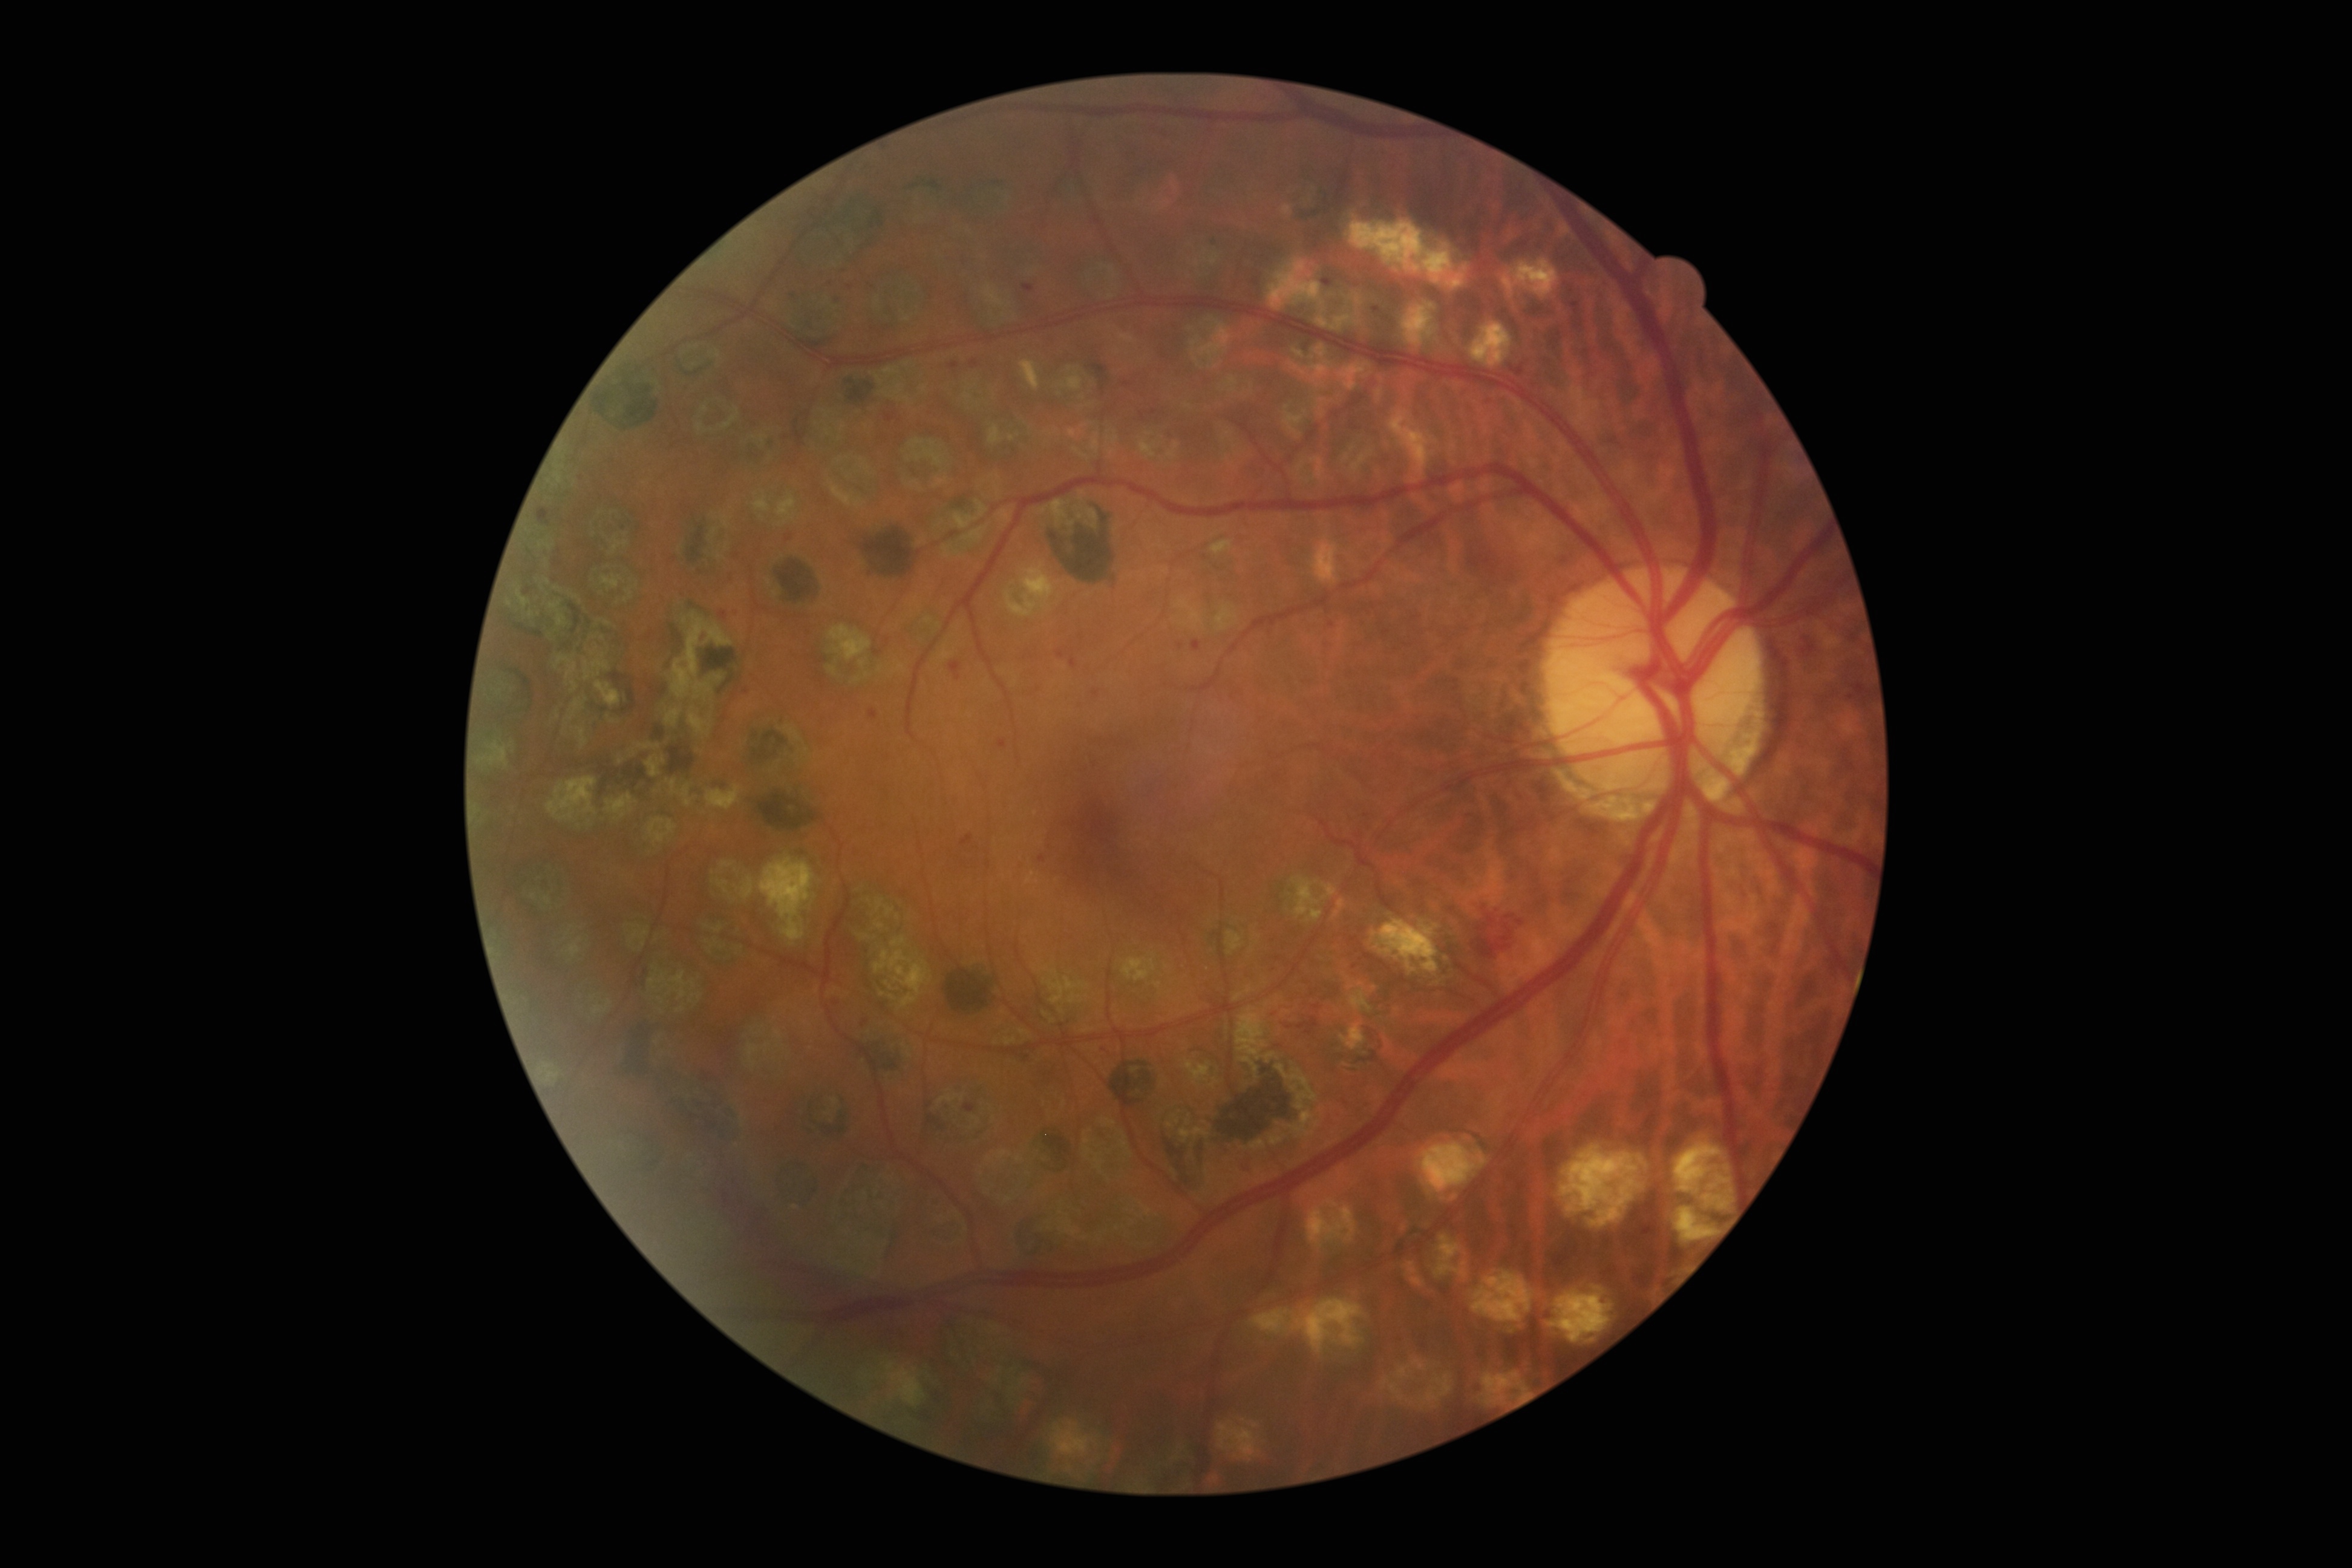 DR grade: 2.